Image size 2352x1568. Retinal fundus photograph. FOV: 45 degrees.
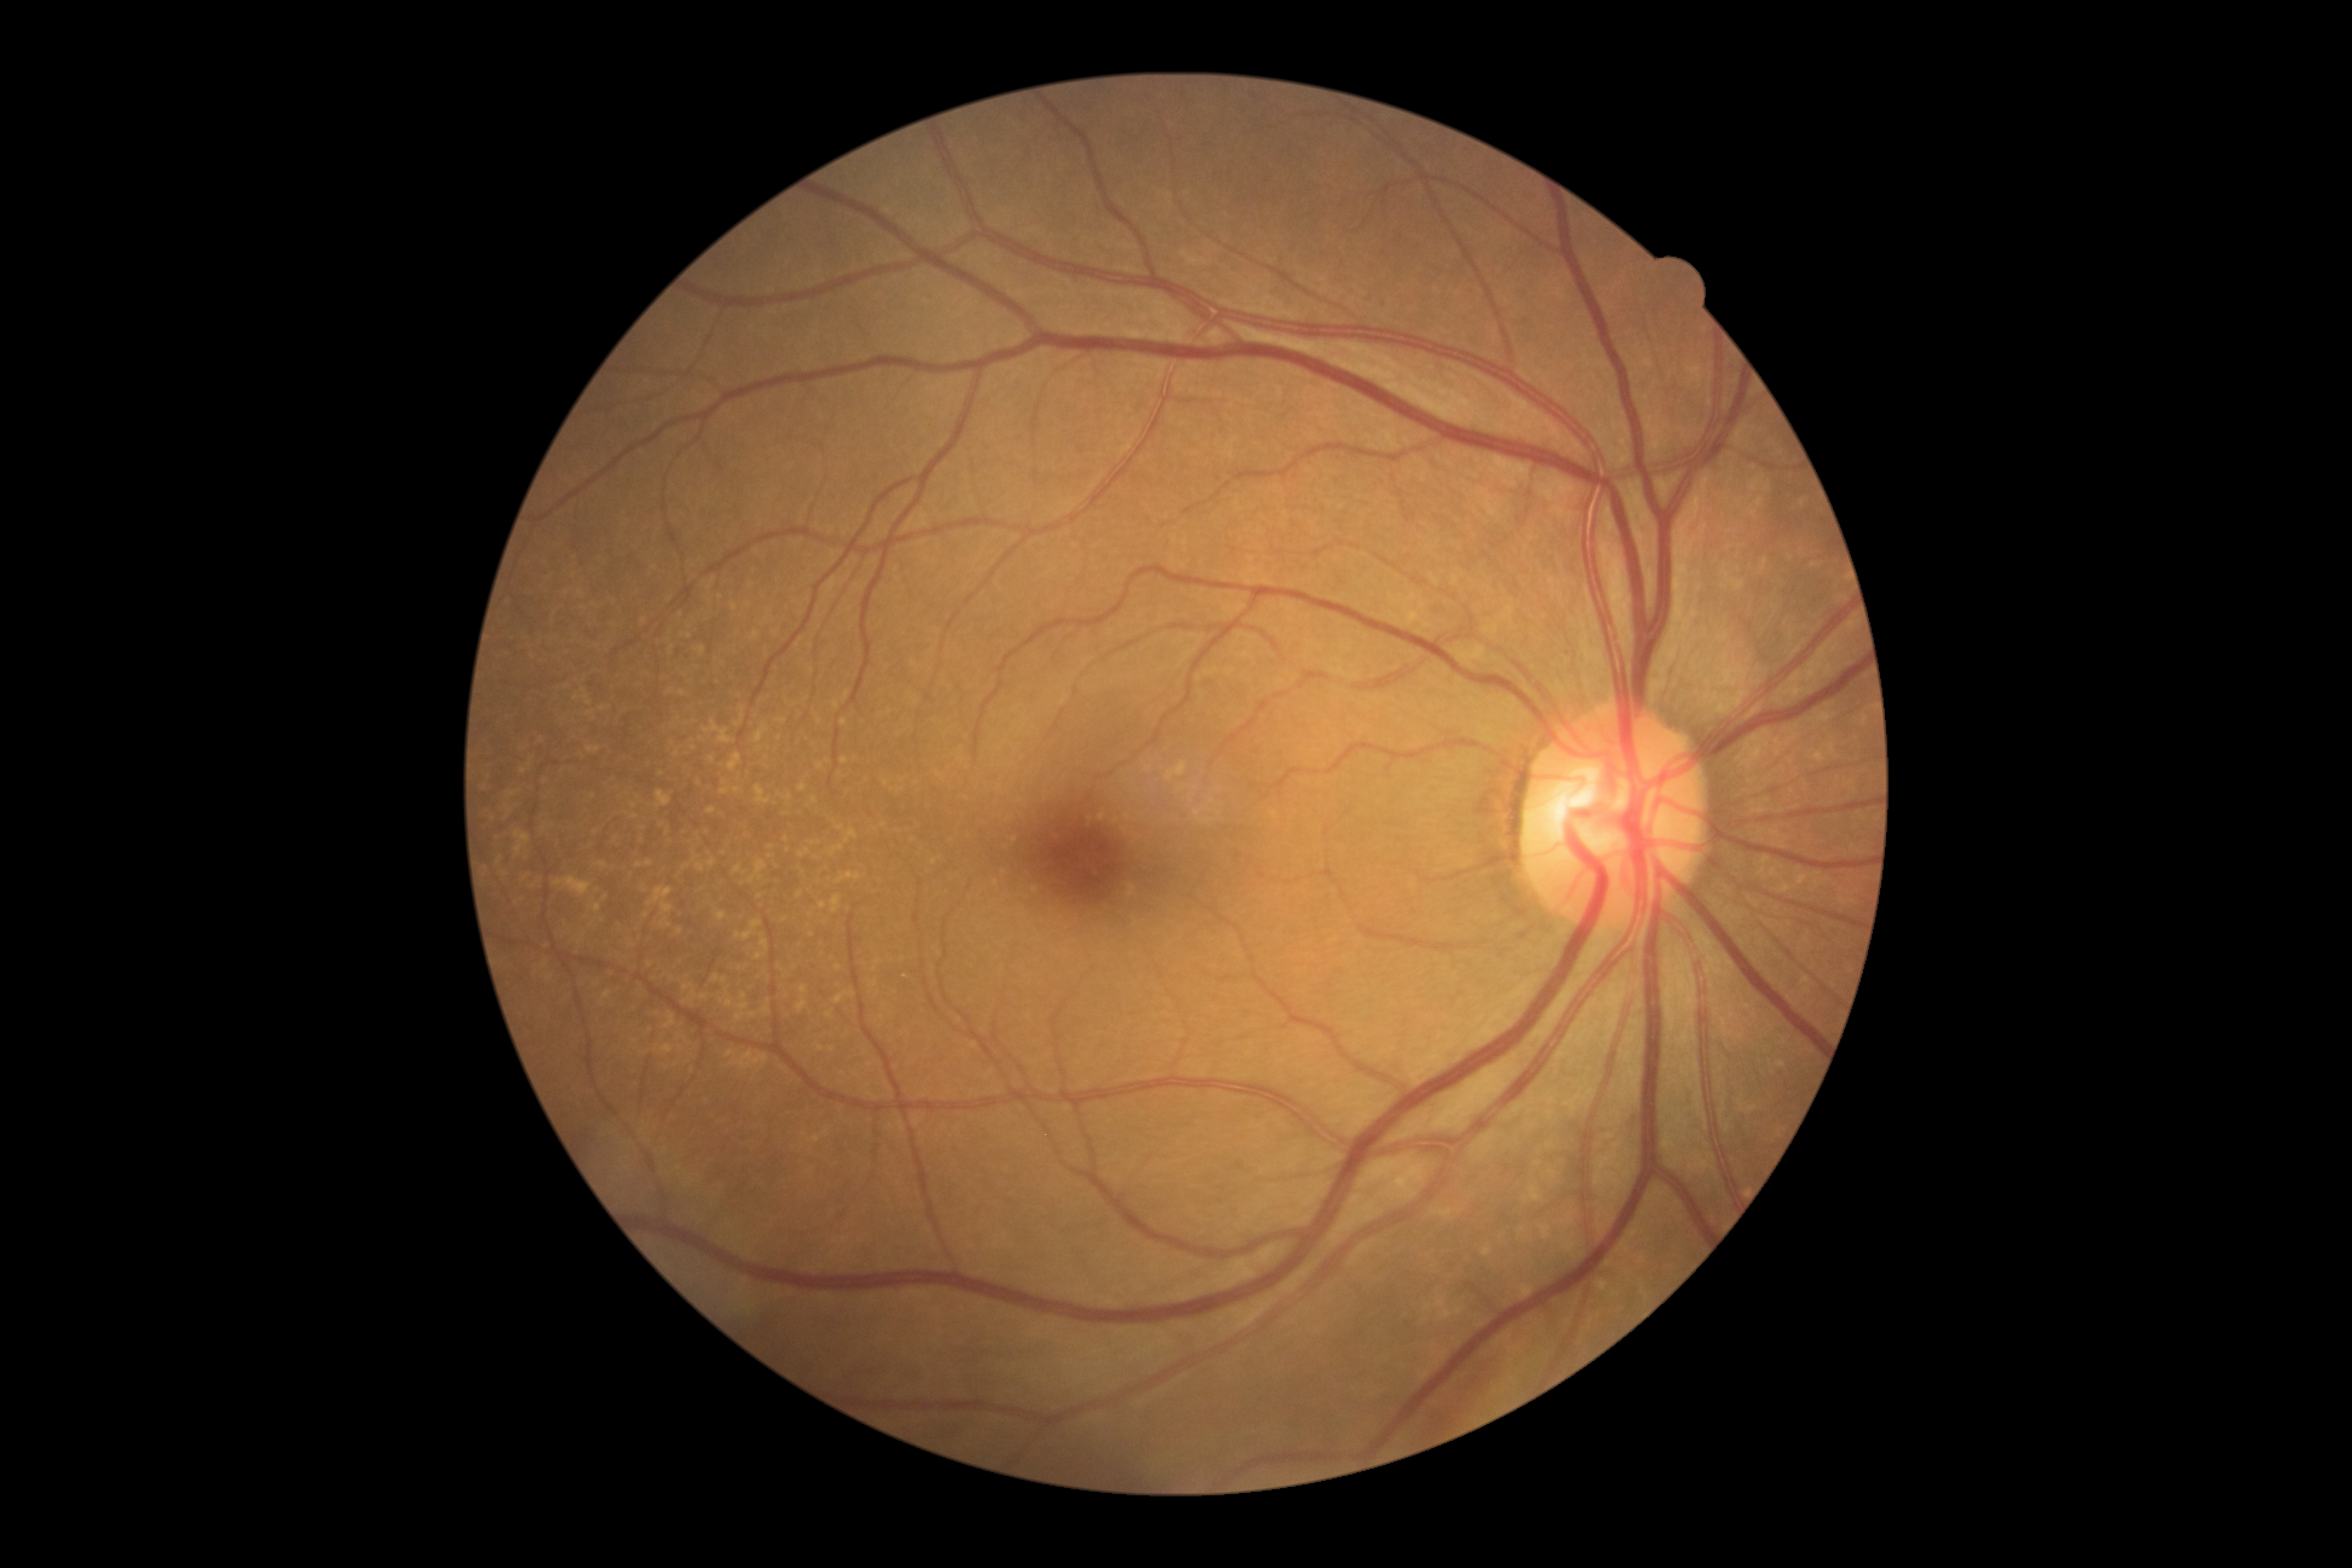

DR stage: grade 0. No diabetic retinal disease findings.